2048x1536px:
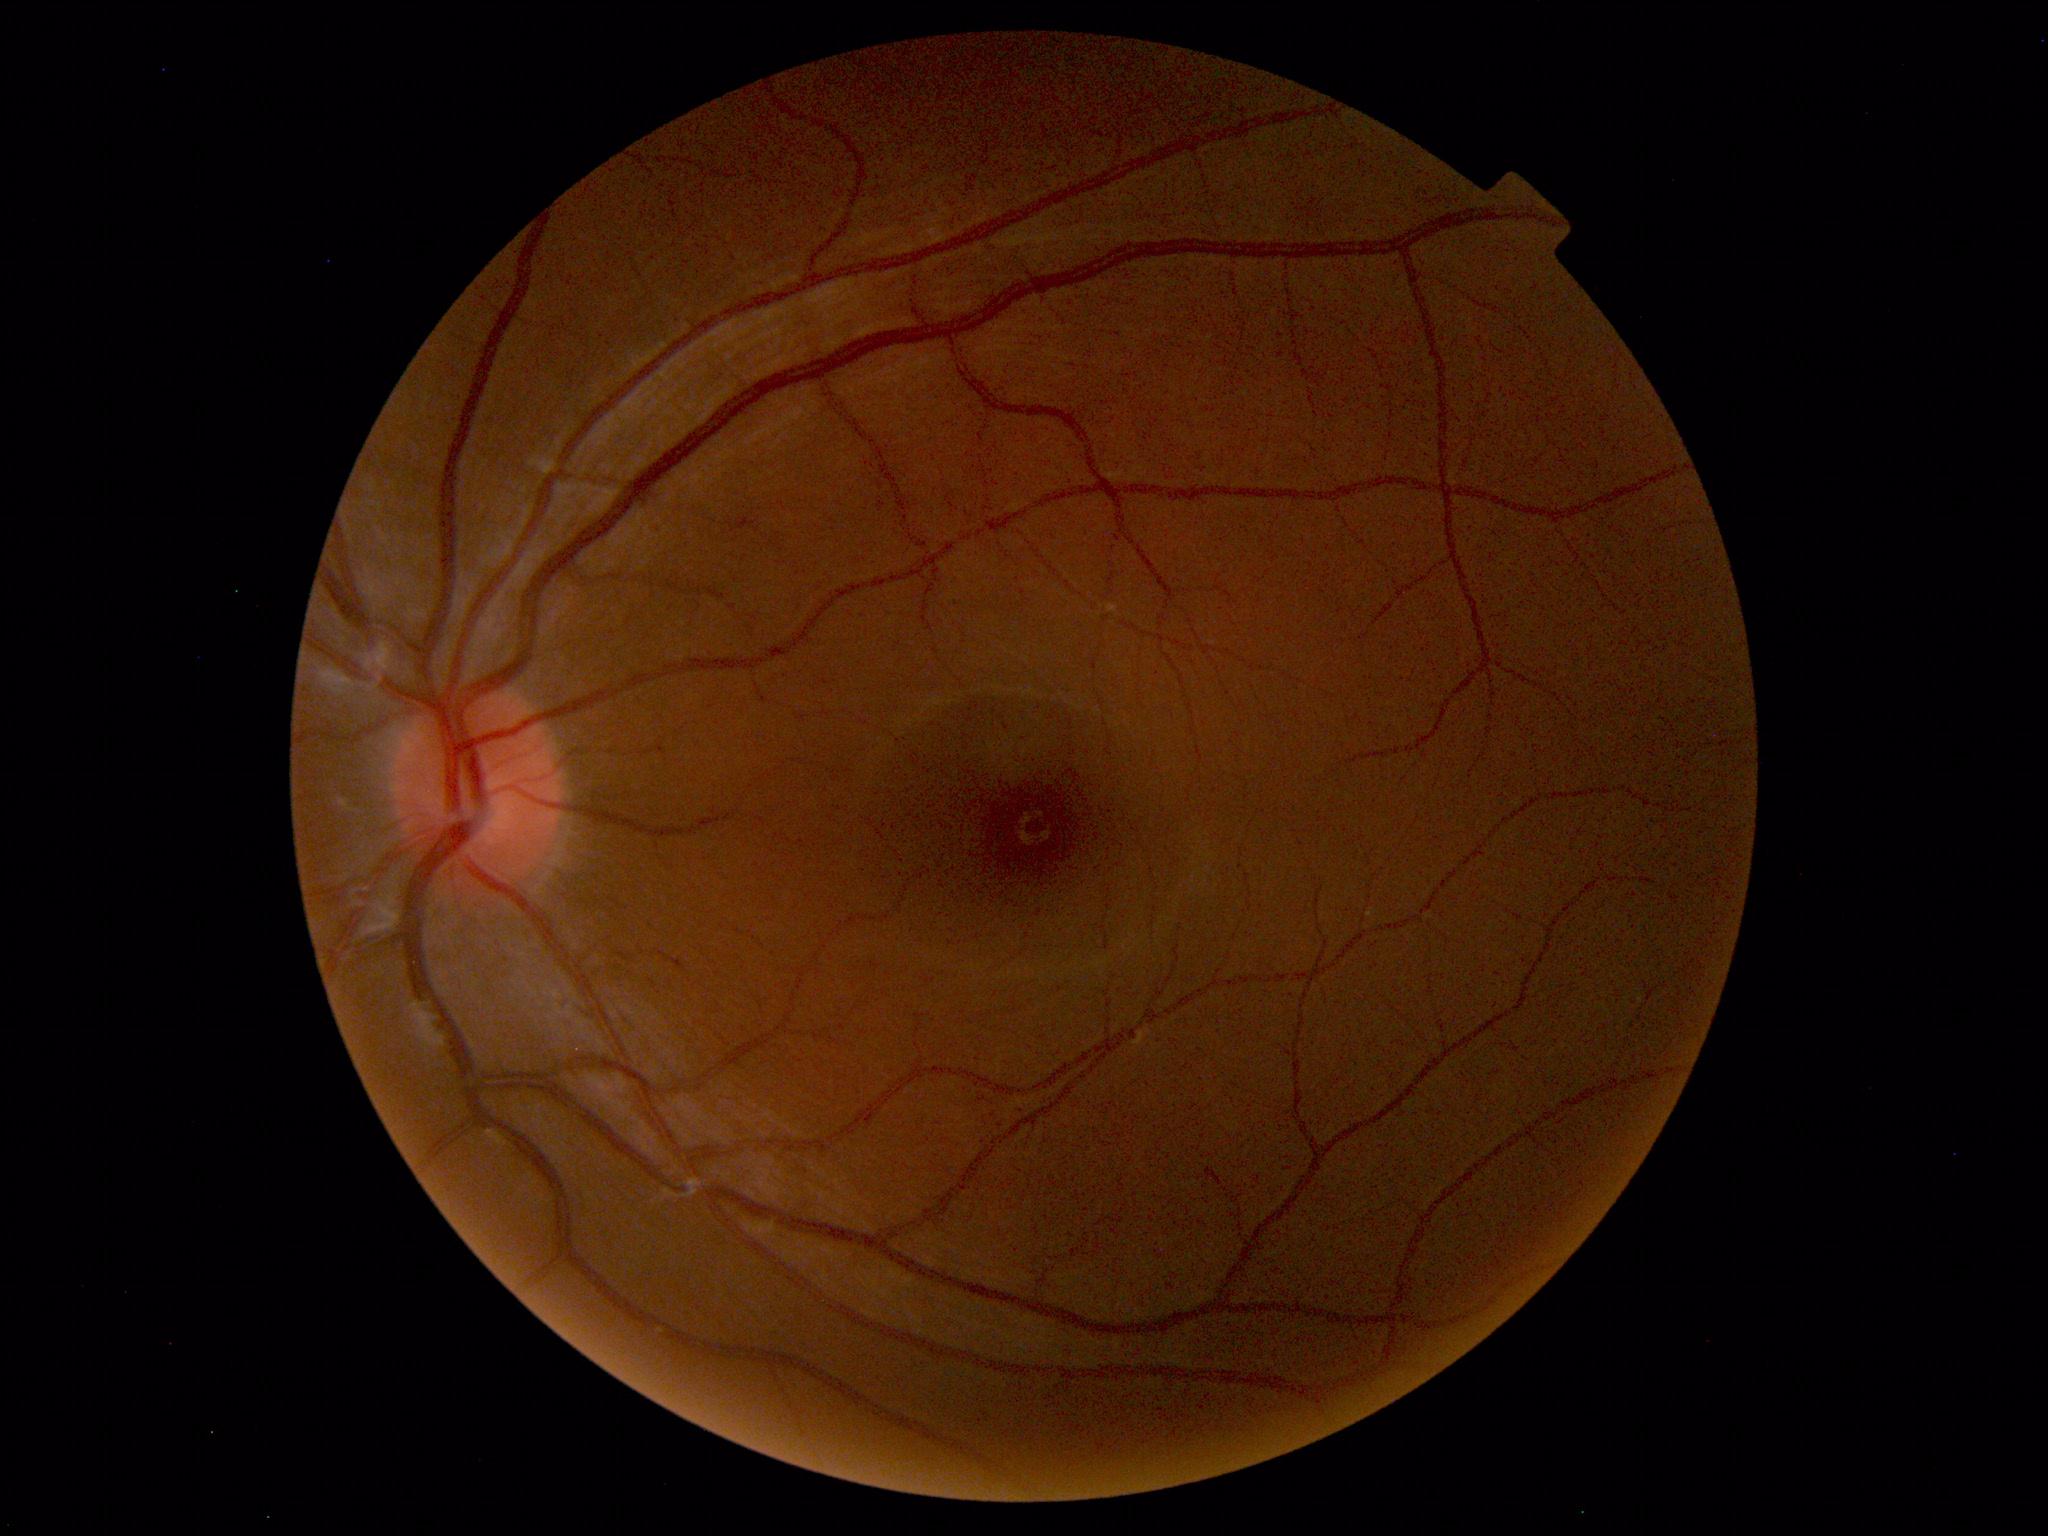

The fundus appears normal with no pathological findings.